Without pupil dilation · image size 848x848.
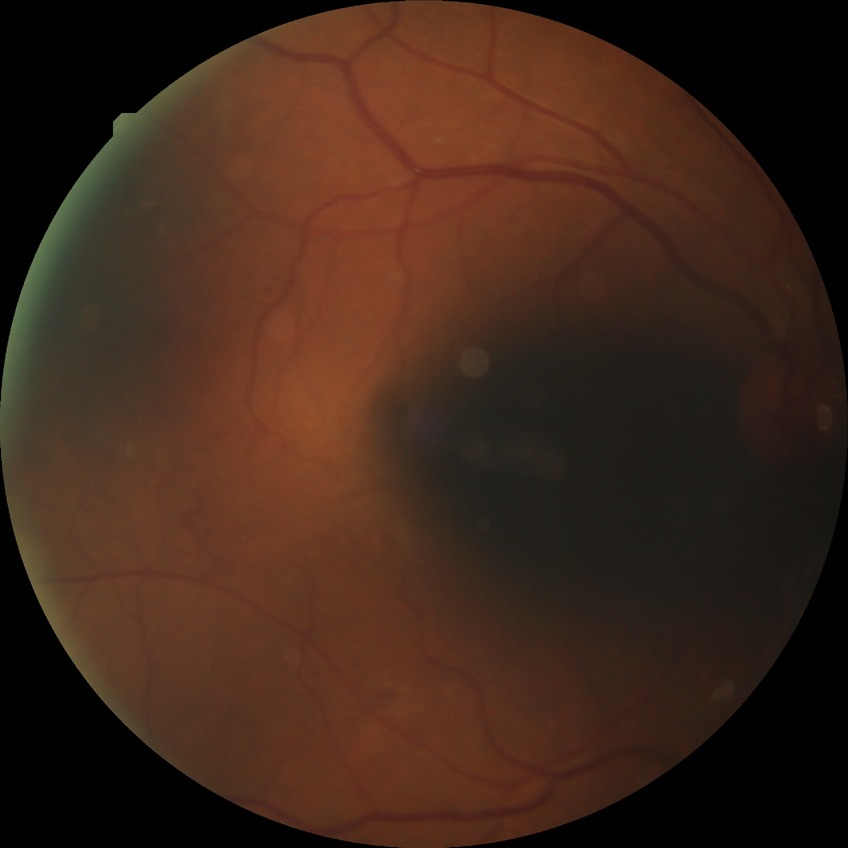

Diabetic retinopathy (DR) is simple diabetic retinopathy (SDR).